848x848 · 45° FOV · NIDEK AFC-230 · nonmydriatic fundus photograph:
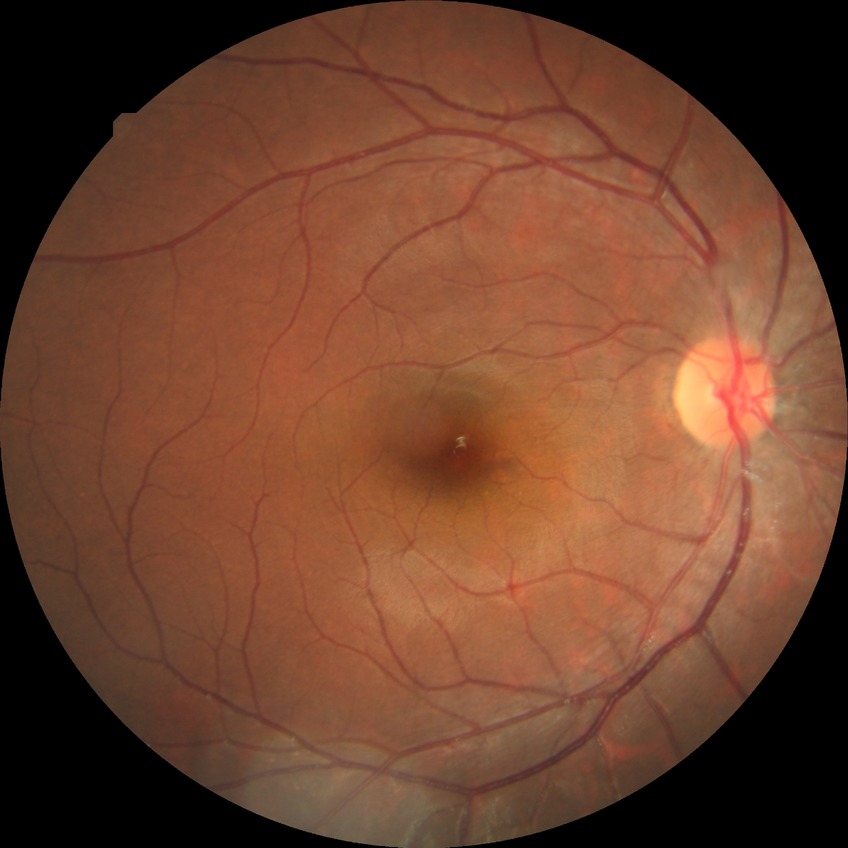

Modified Davis classification: no diabetic retinopathy.